Tabletop color fundus camera image:
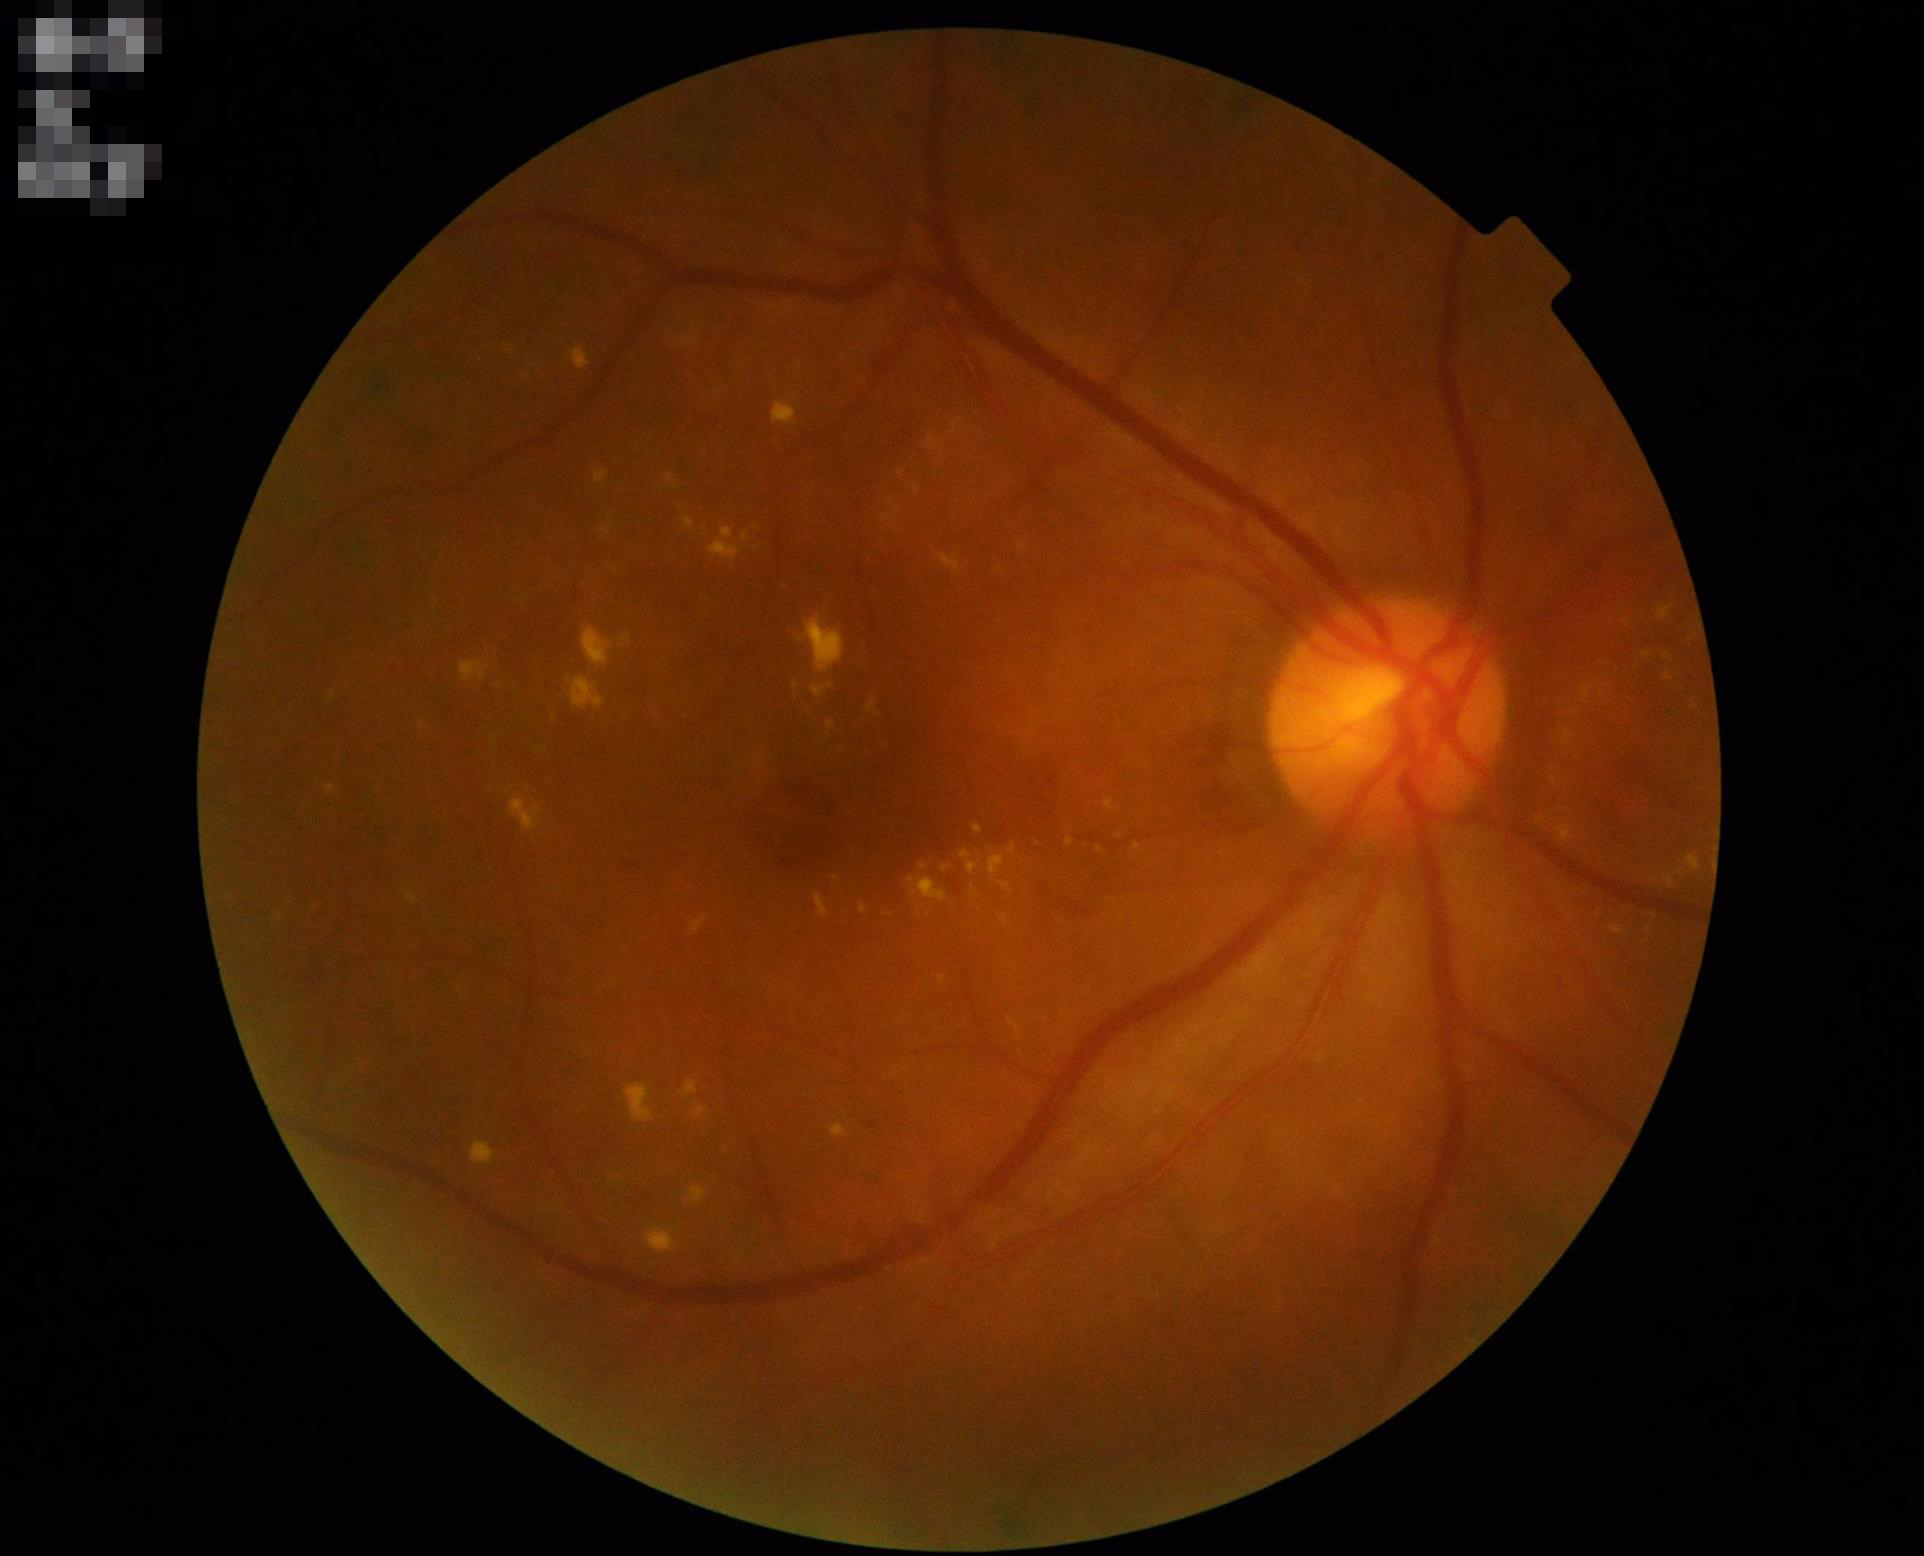
Image quality is adequate for diagnostic use. The image is clear. No over- or under-exposure. Vessels and details are readily distinguishable.